Ultra-widefield fundus photograph — 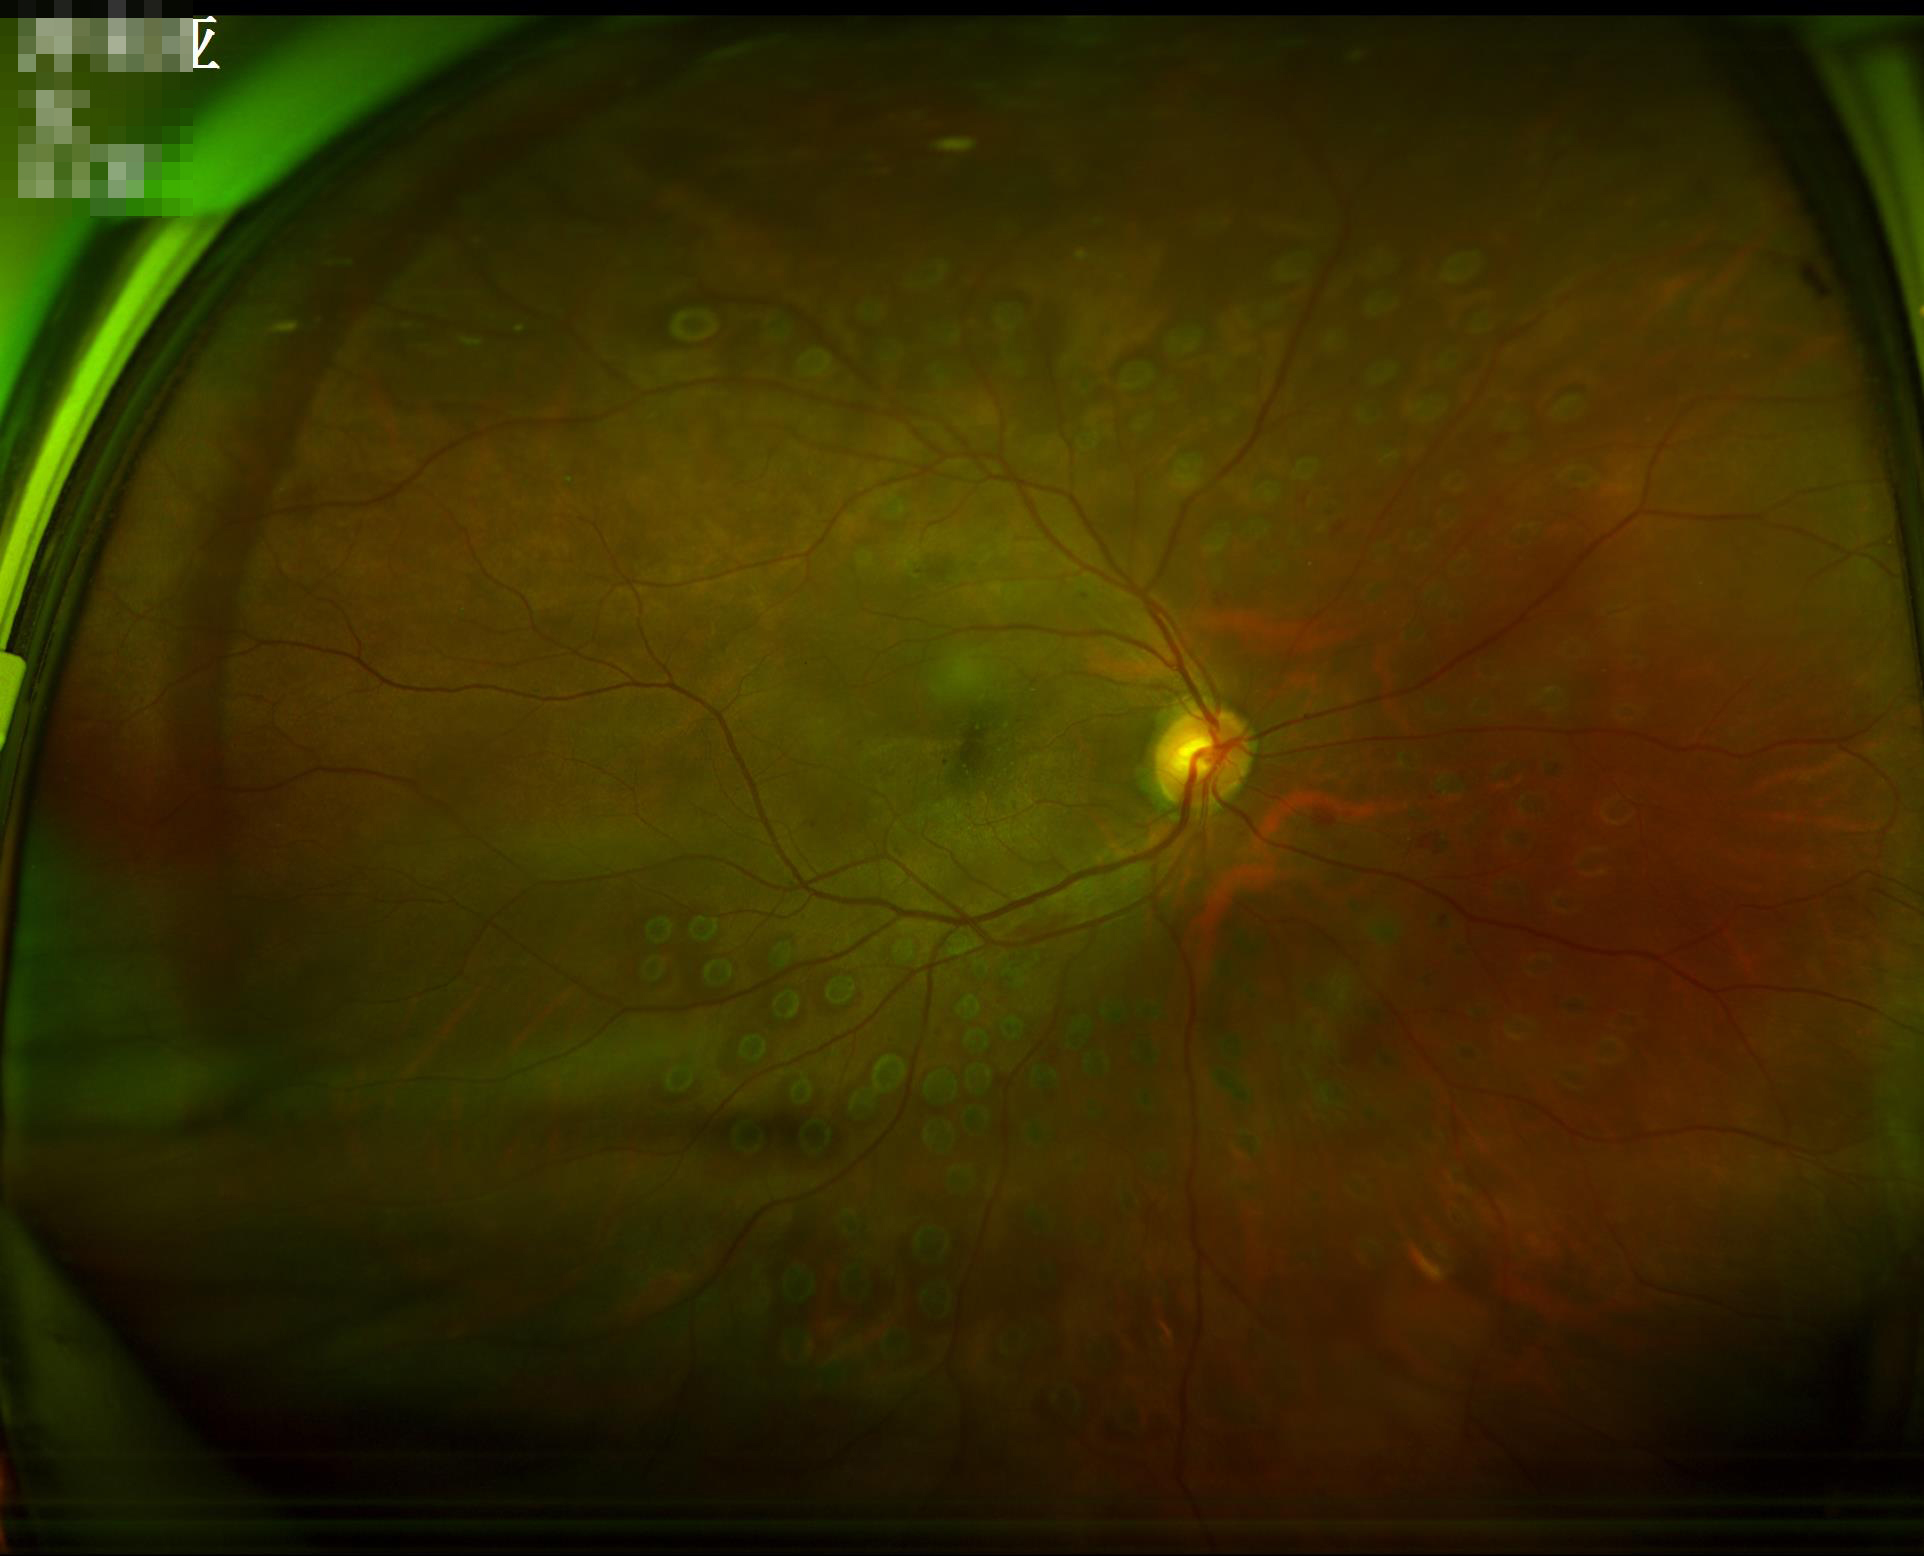

Focus: clear | Contrast: good | Illumination: good.